Portable fundus photograph:
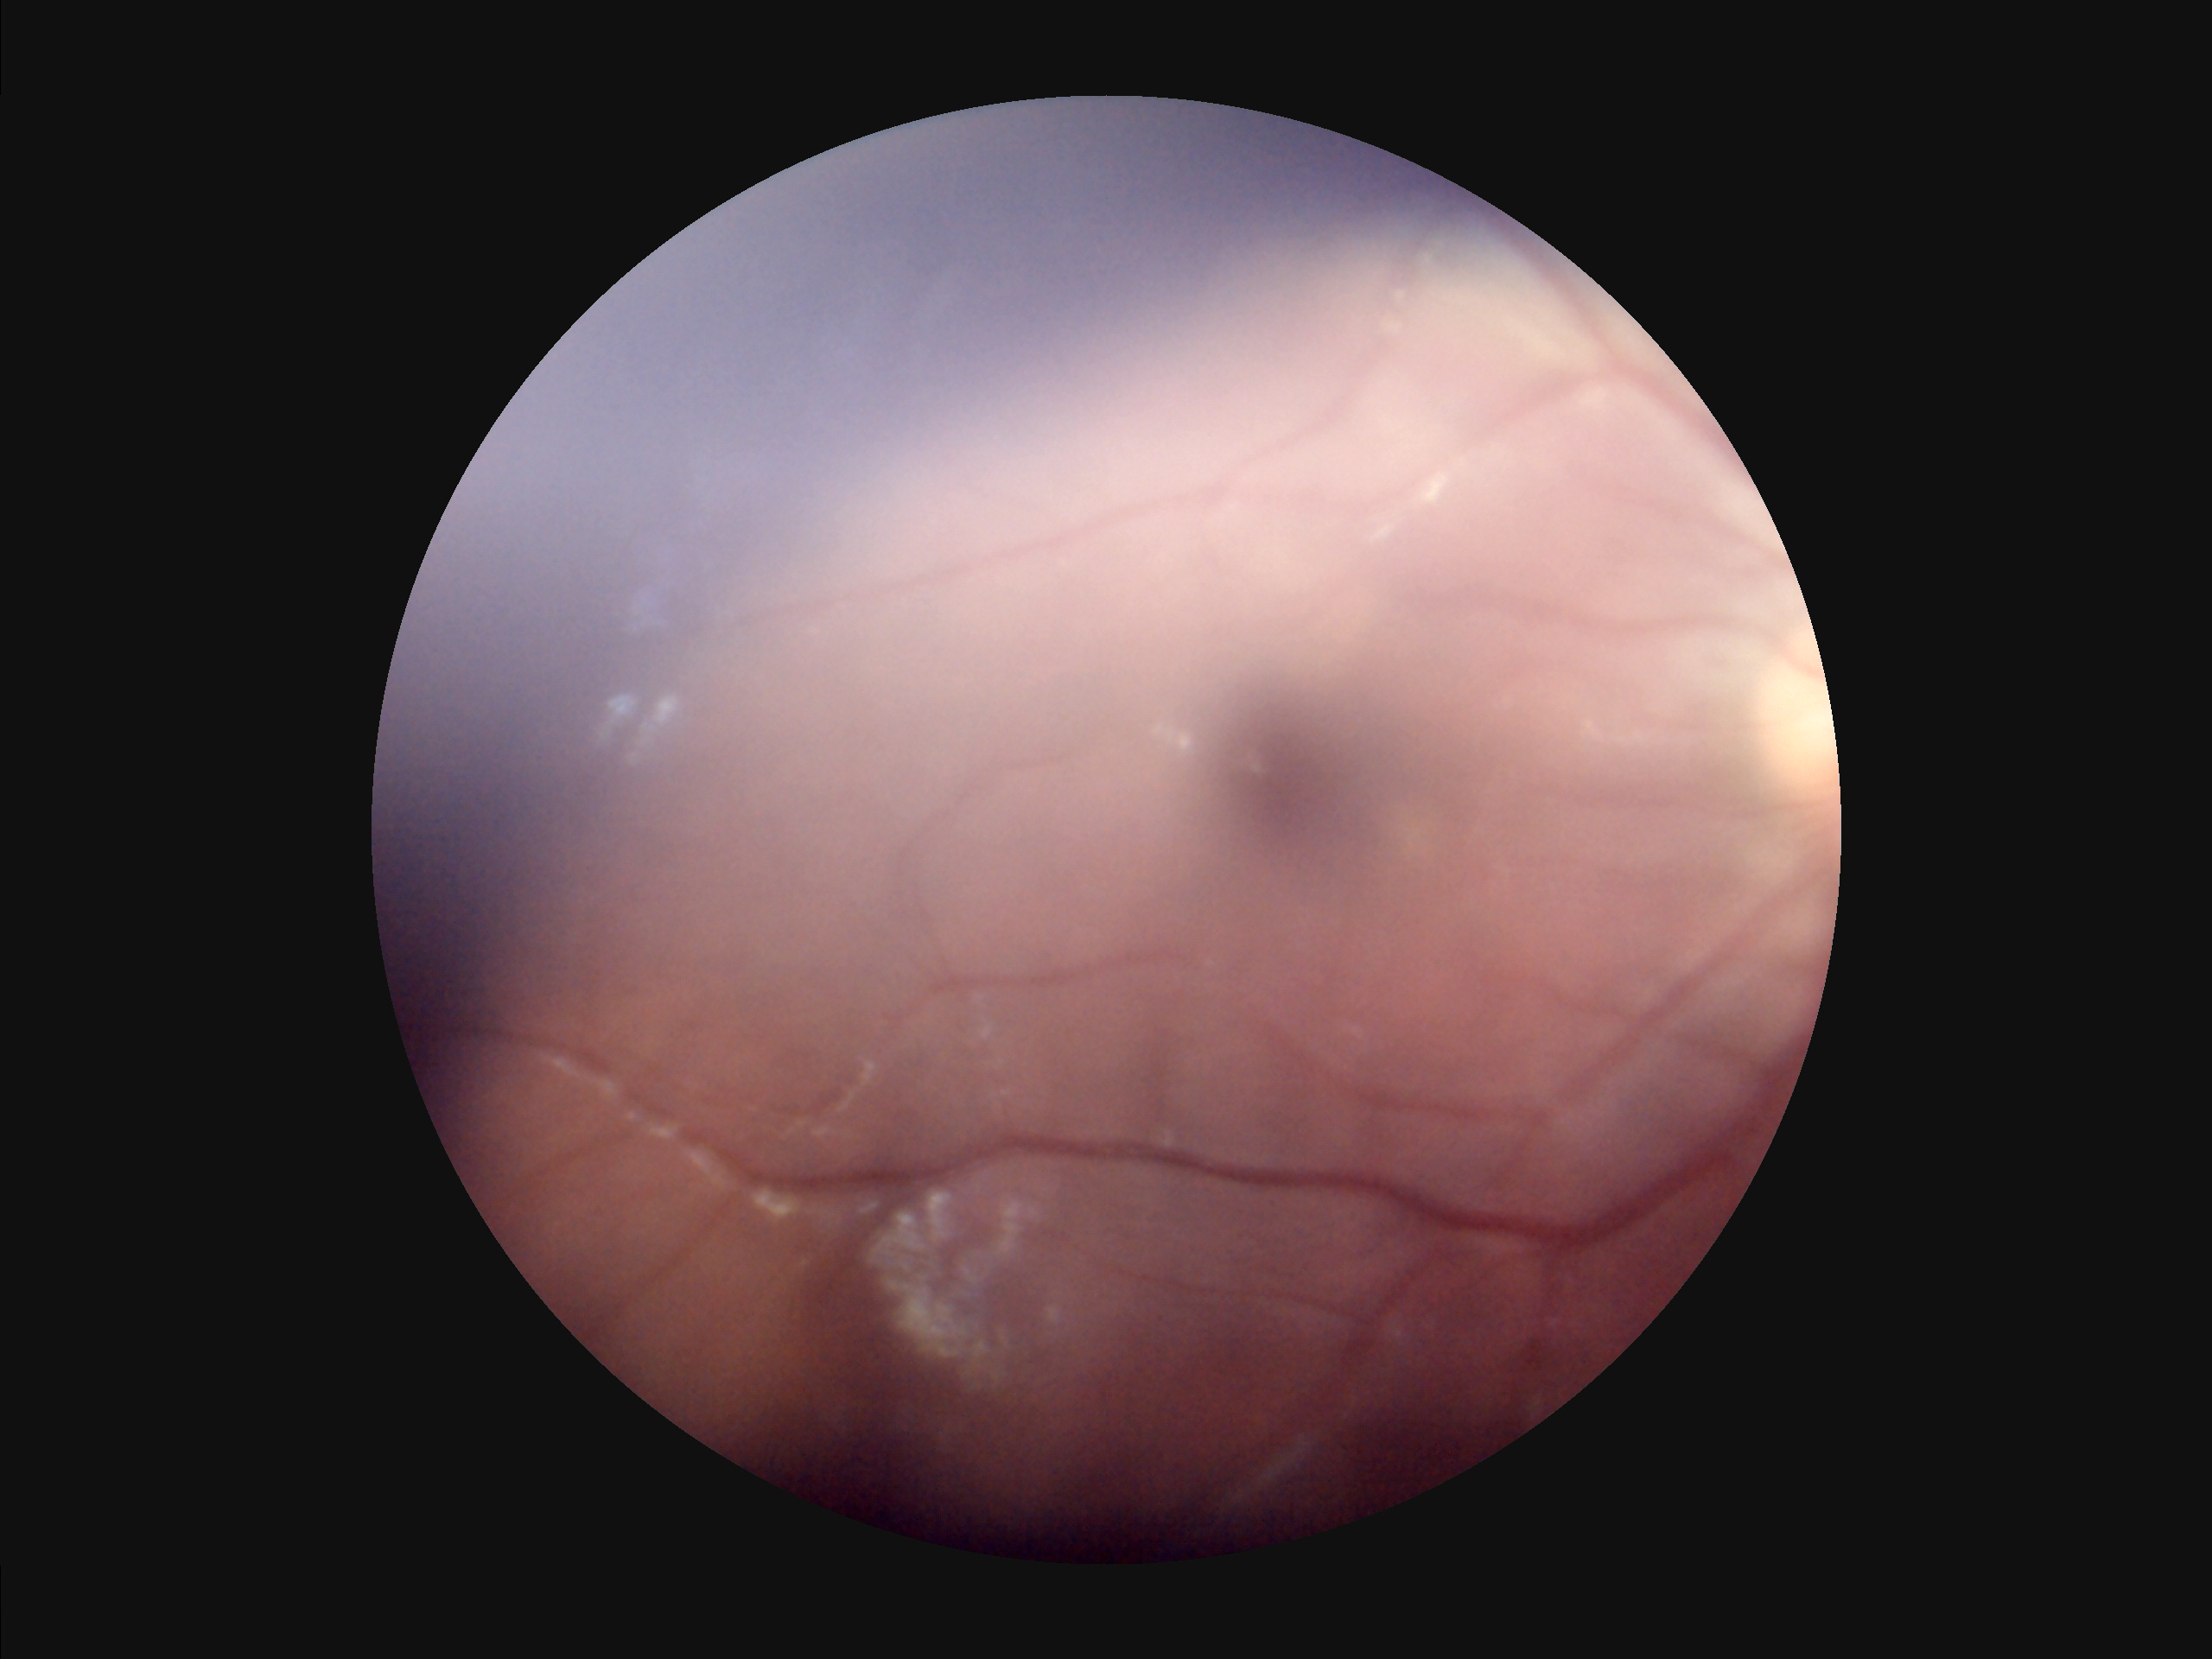
Image quality: illumination: over- or under-exposed | overall: poor, ungradable | sharpness: reduced sharpness with visible blur | contrast: low, vessels and details hard to distinguish.